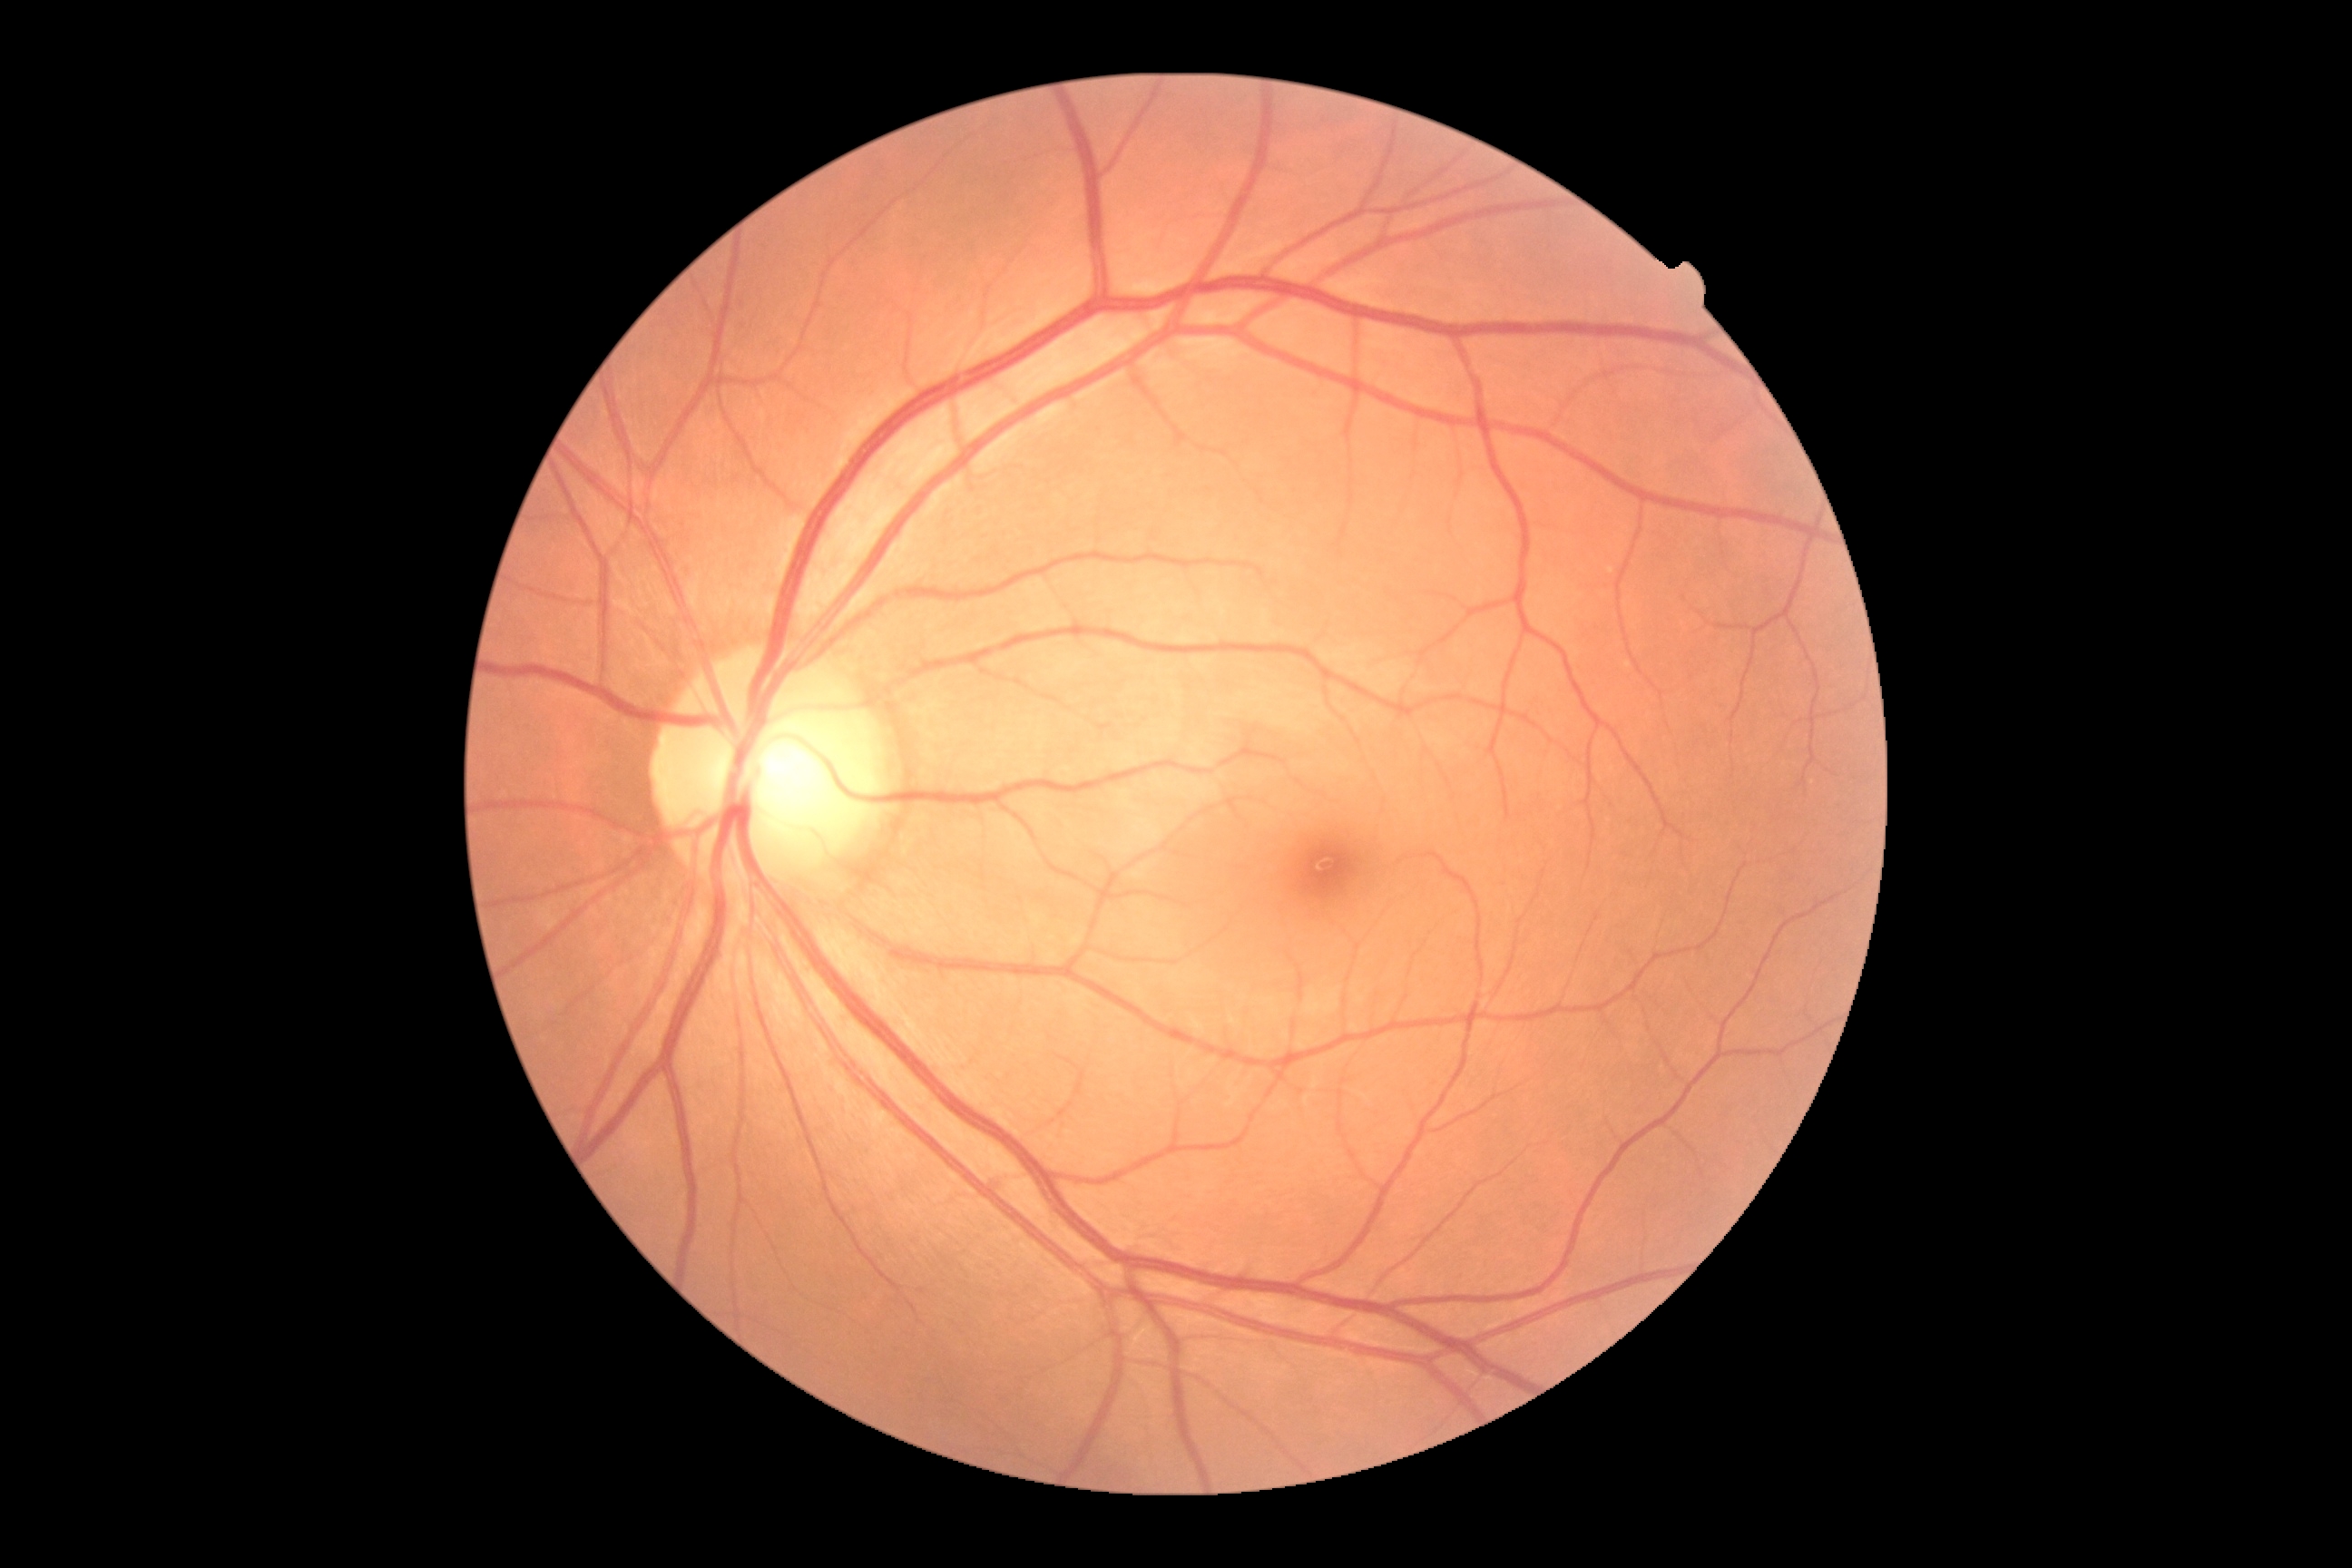
No apparent diabetic retinopathy.
Diabetic retinopathy severity: no apparent retinopathy (grade 0).